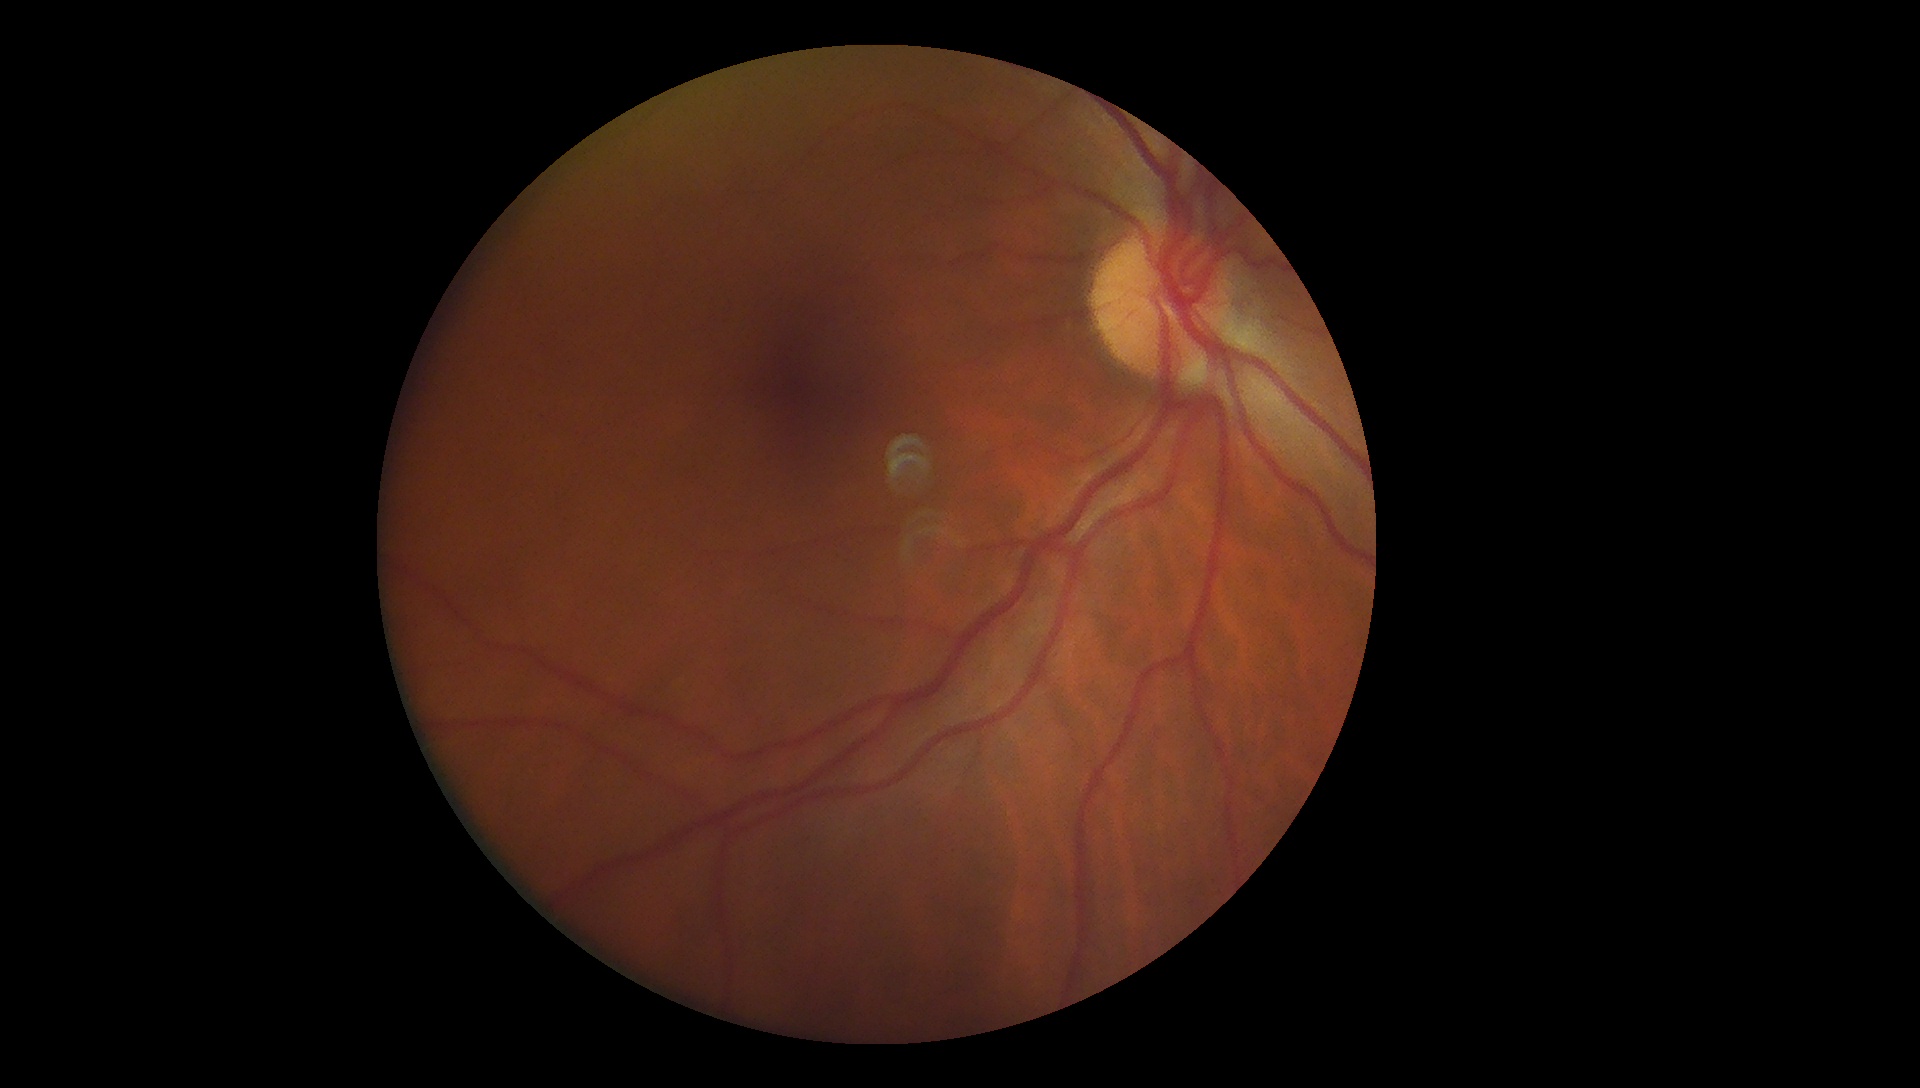 Findings:
* diabetic retinopathy grade — 0 (no apparent retinopathy)
* DR impression — no signs of DR